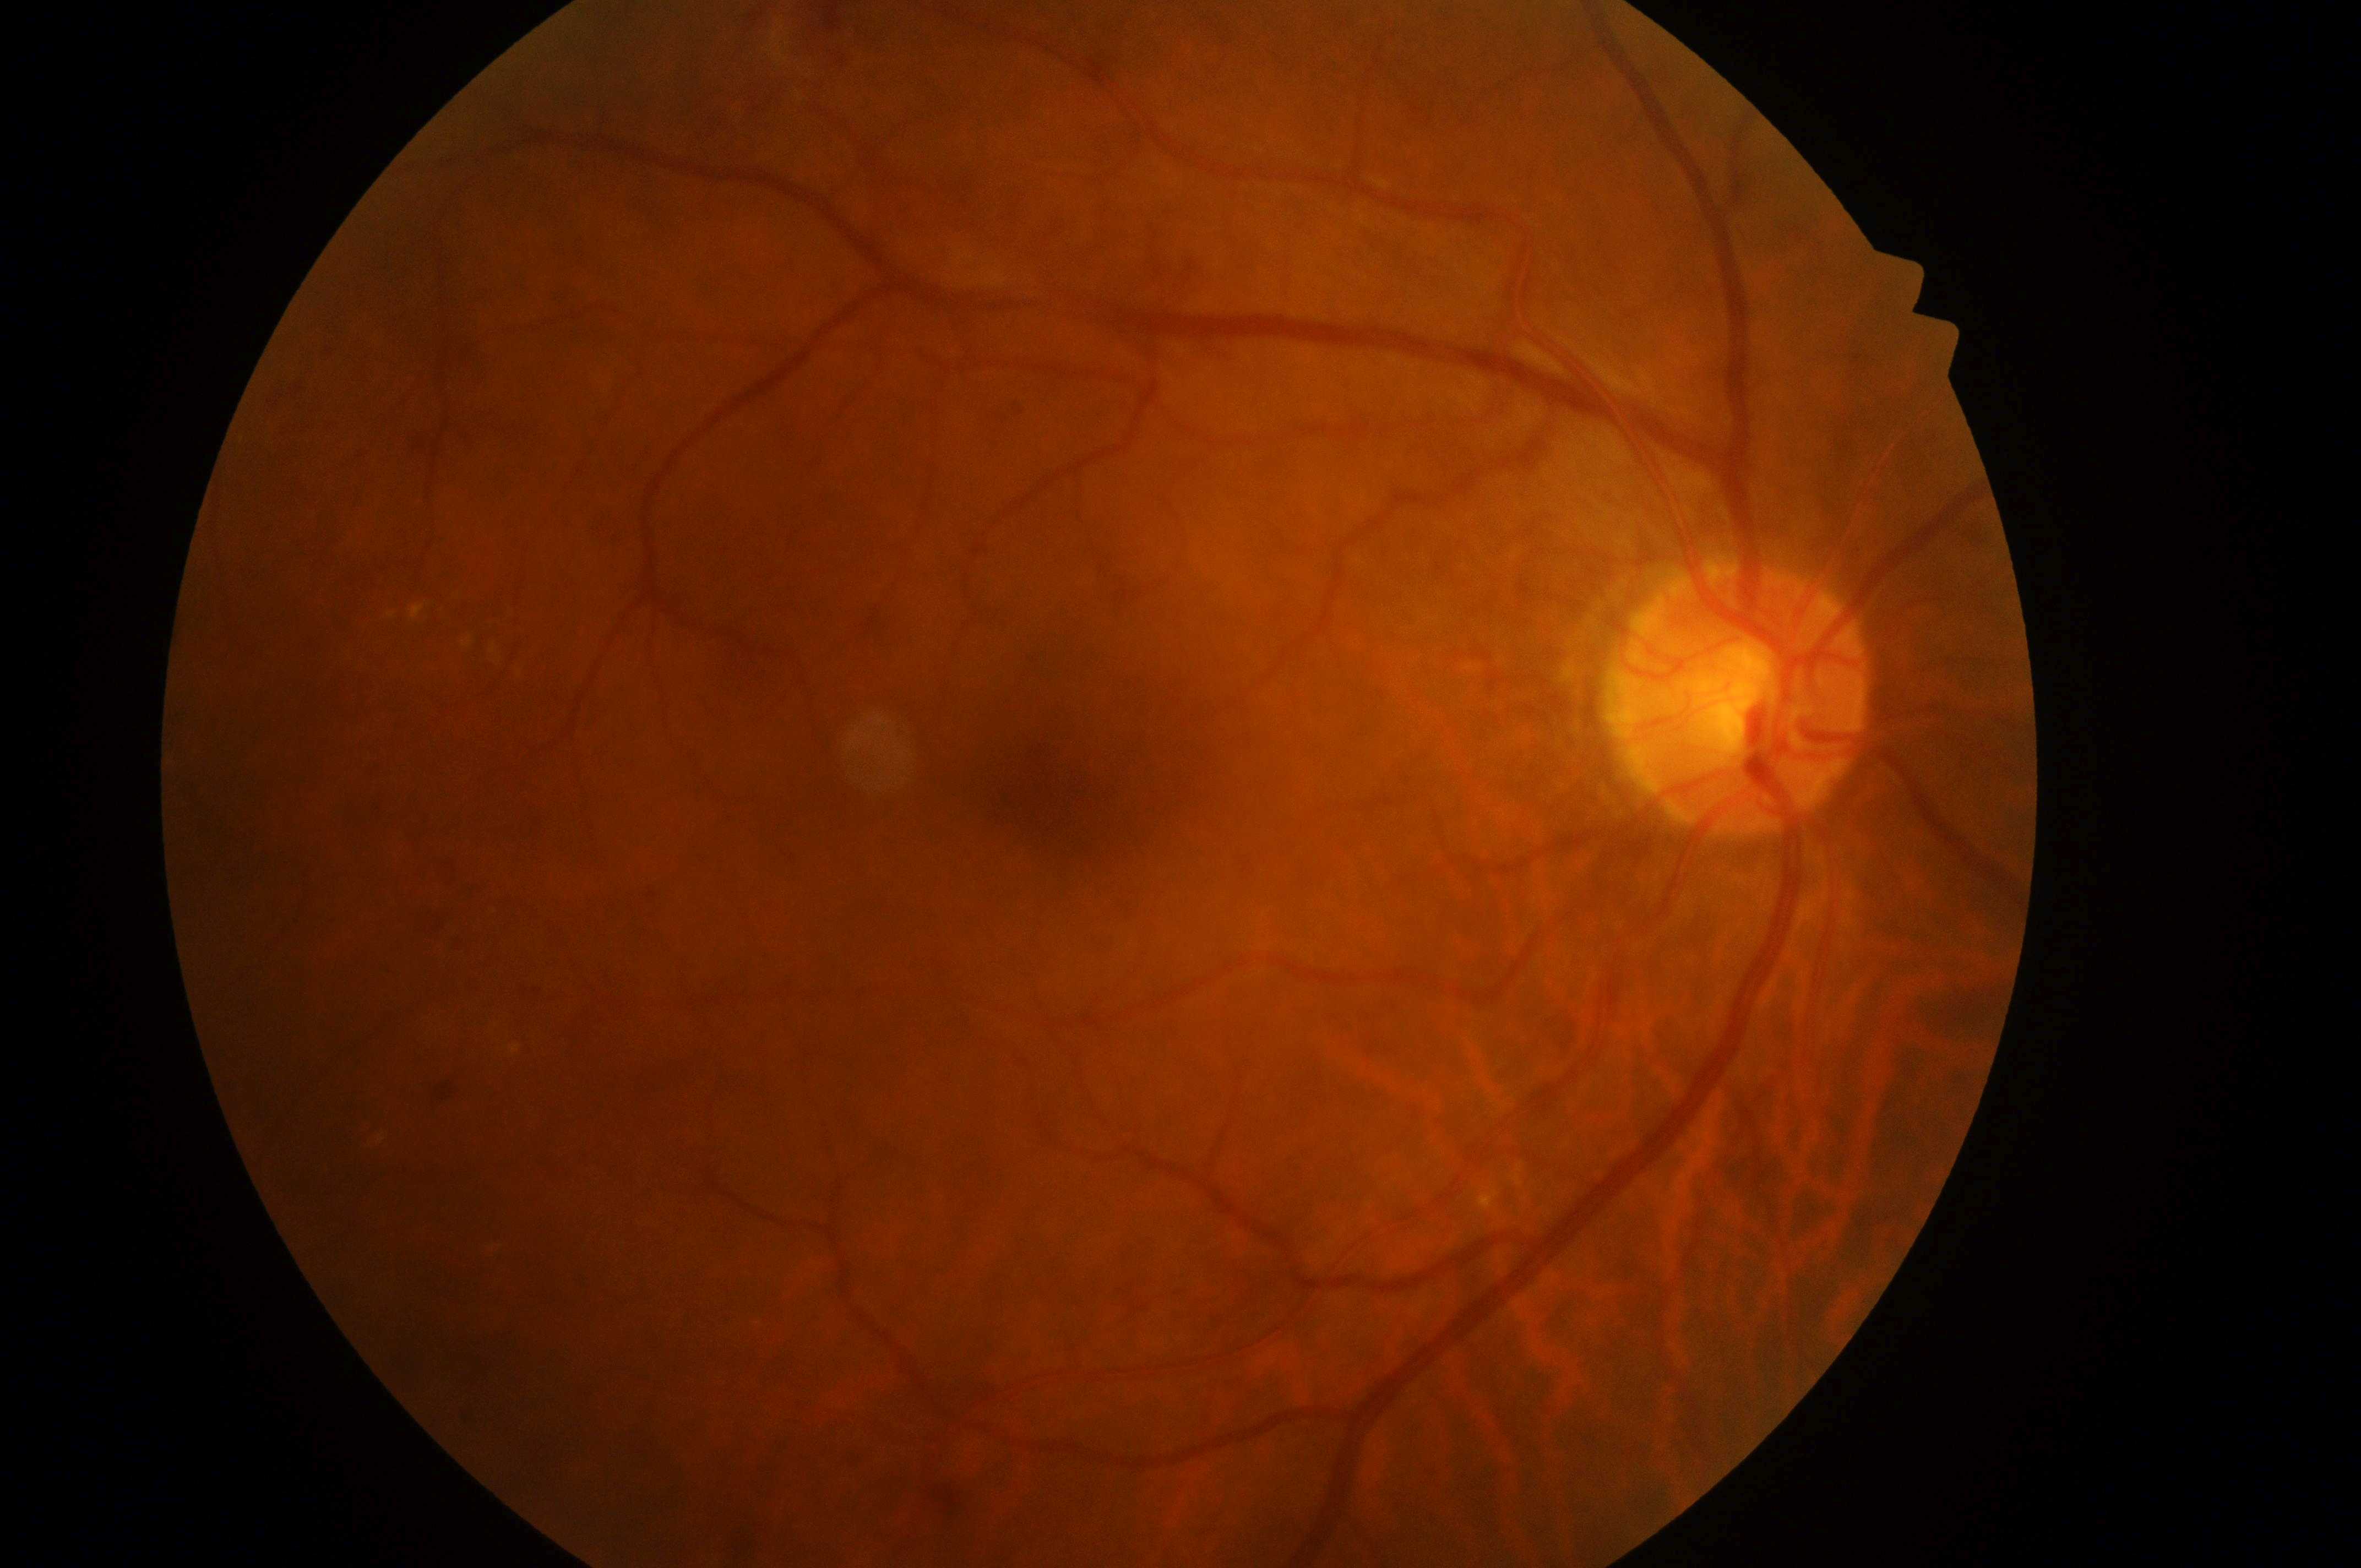

optic disk@1739px, 705px
diabetic macular edema (DME)@grade 1 (low risk)
oculus dexter
diabetic retinopathy (DR)@grade 4 (PDR)
fovea center@1058px, 808px